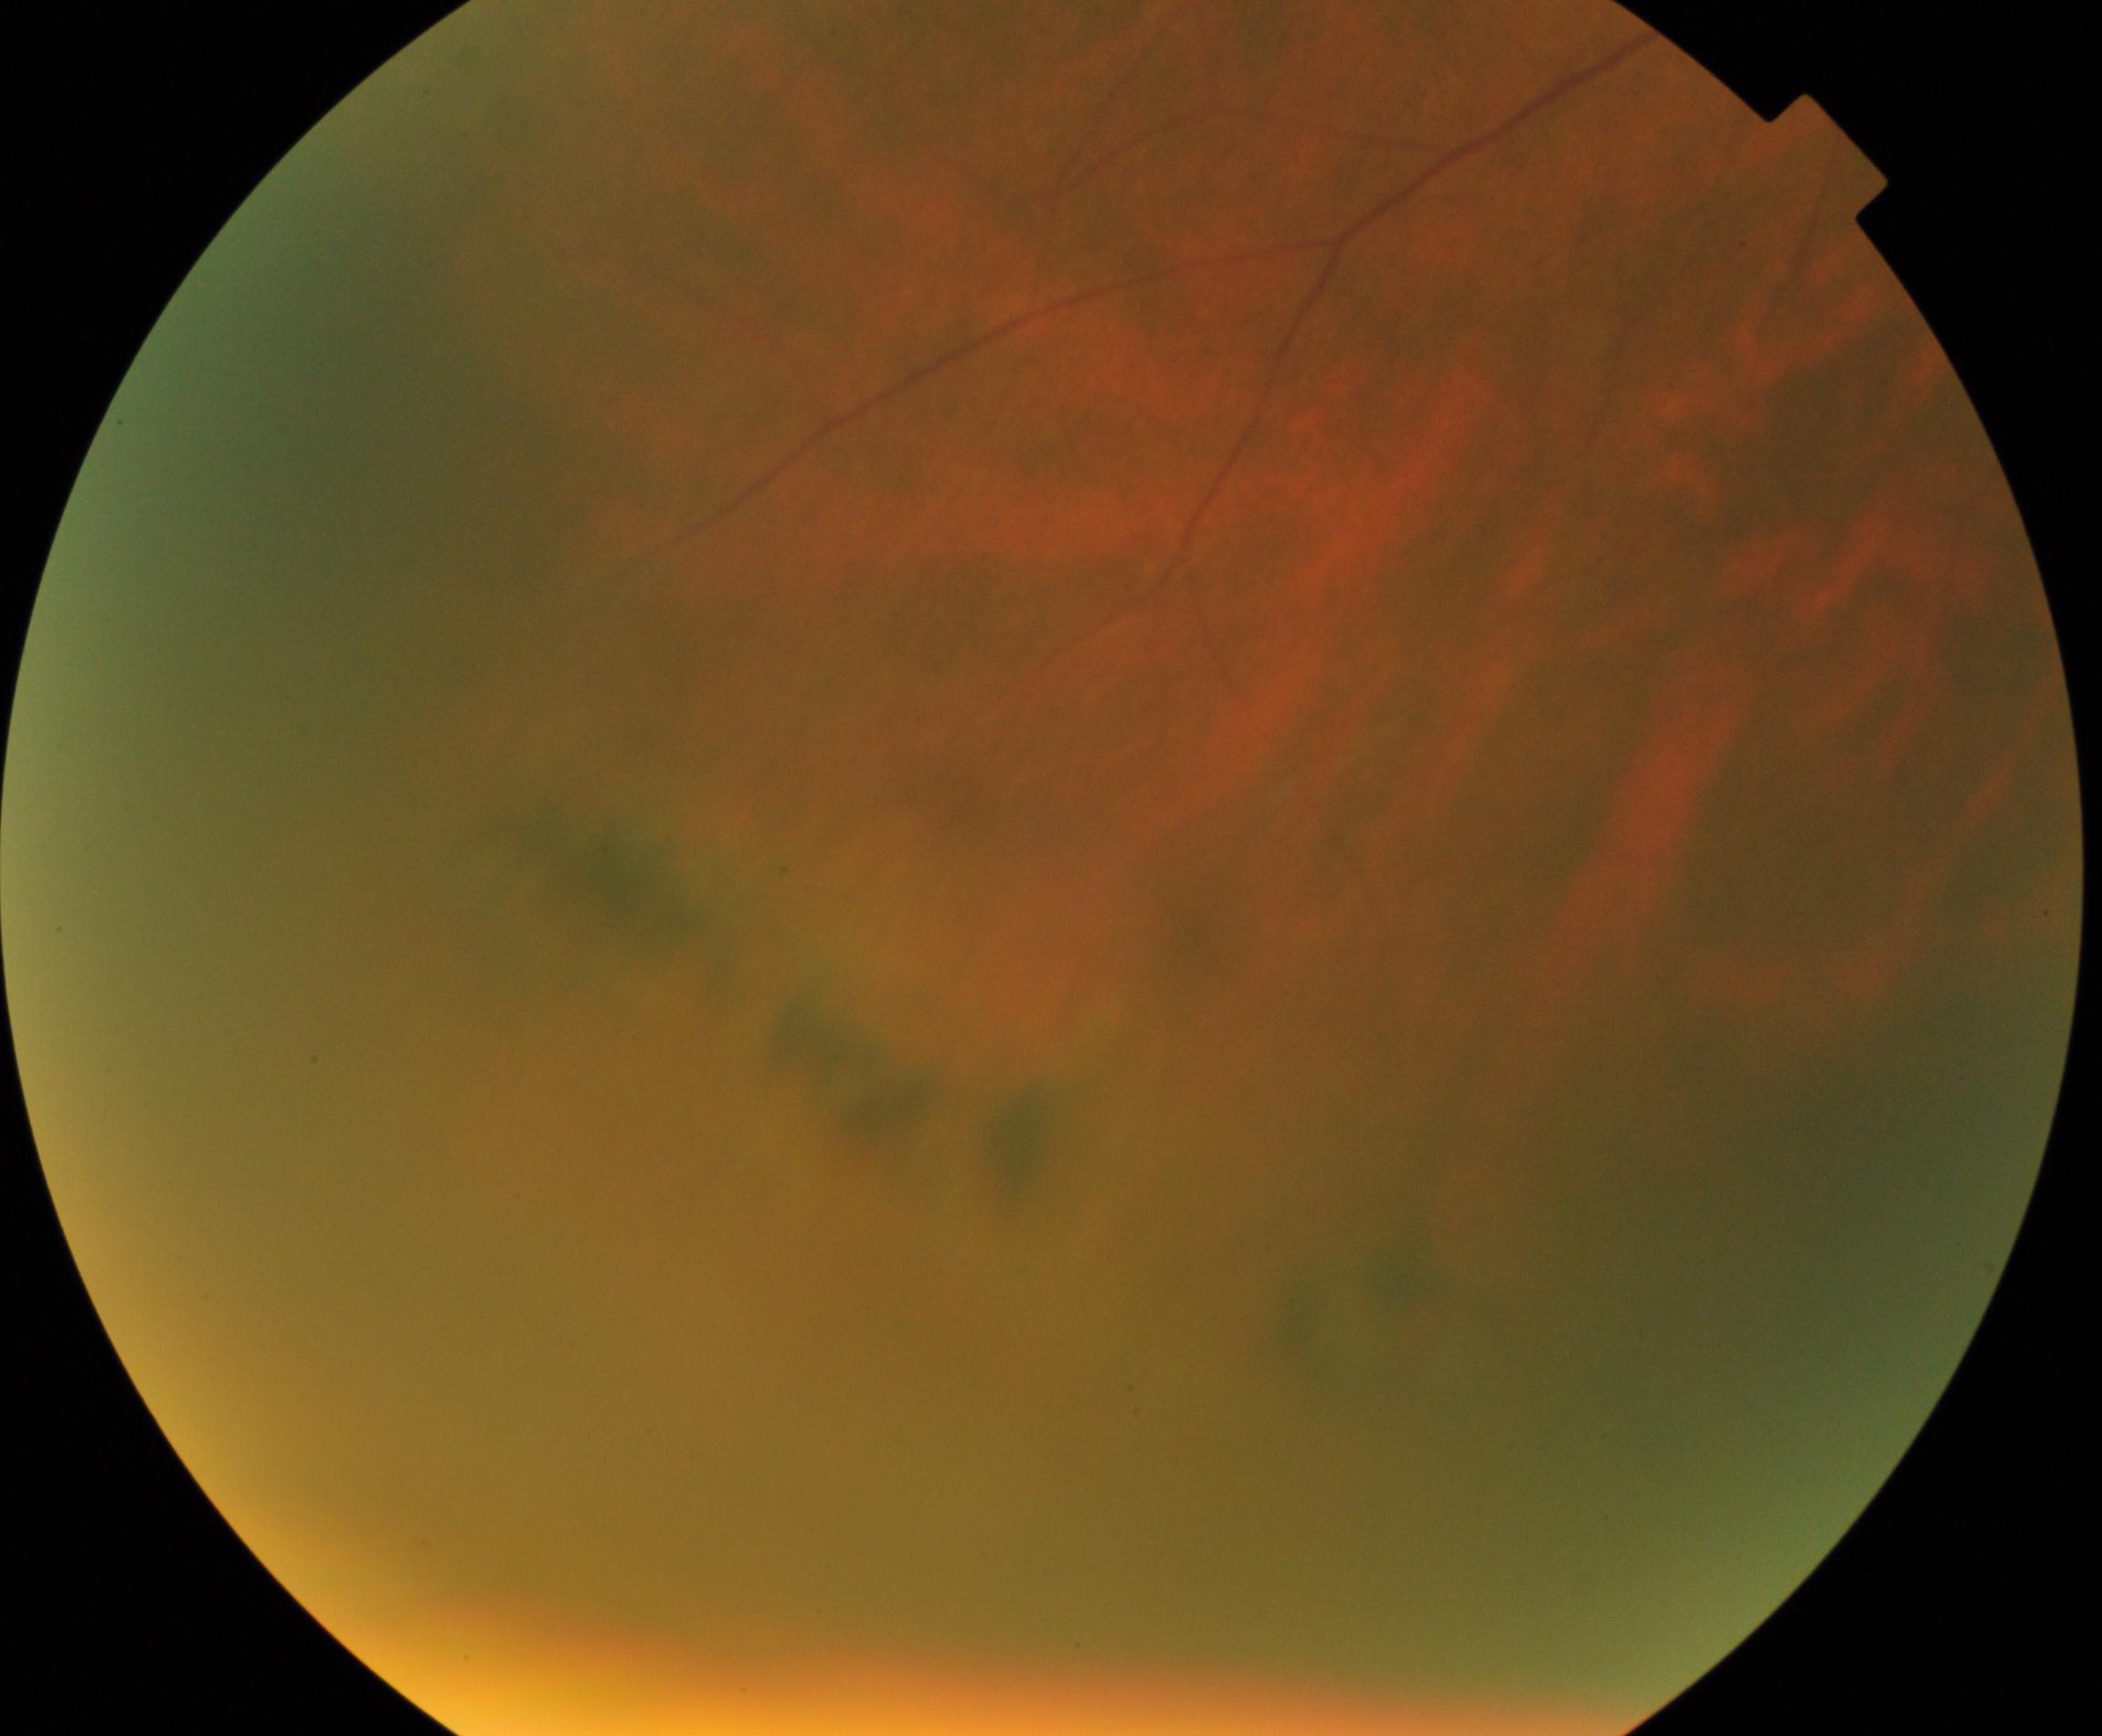

Retinal fundus photograph demonstrating peripheral retinal degeneration and break.